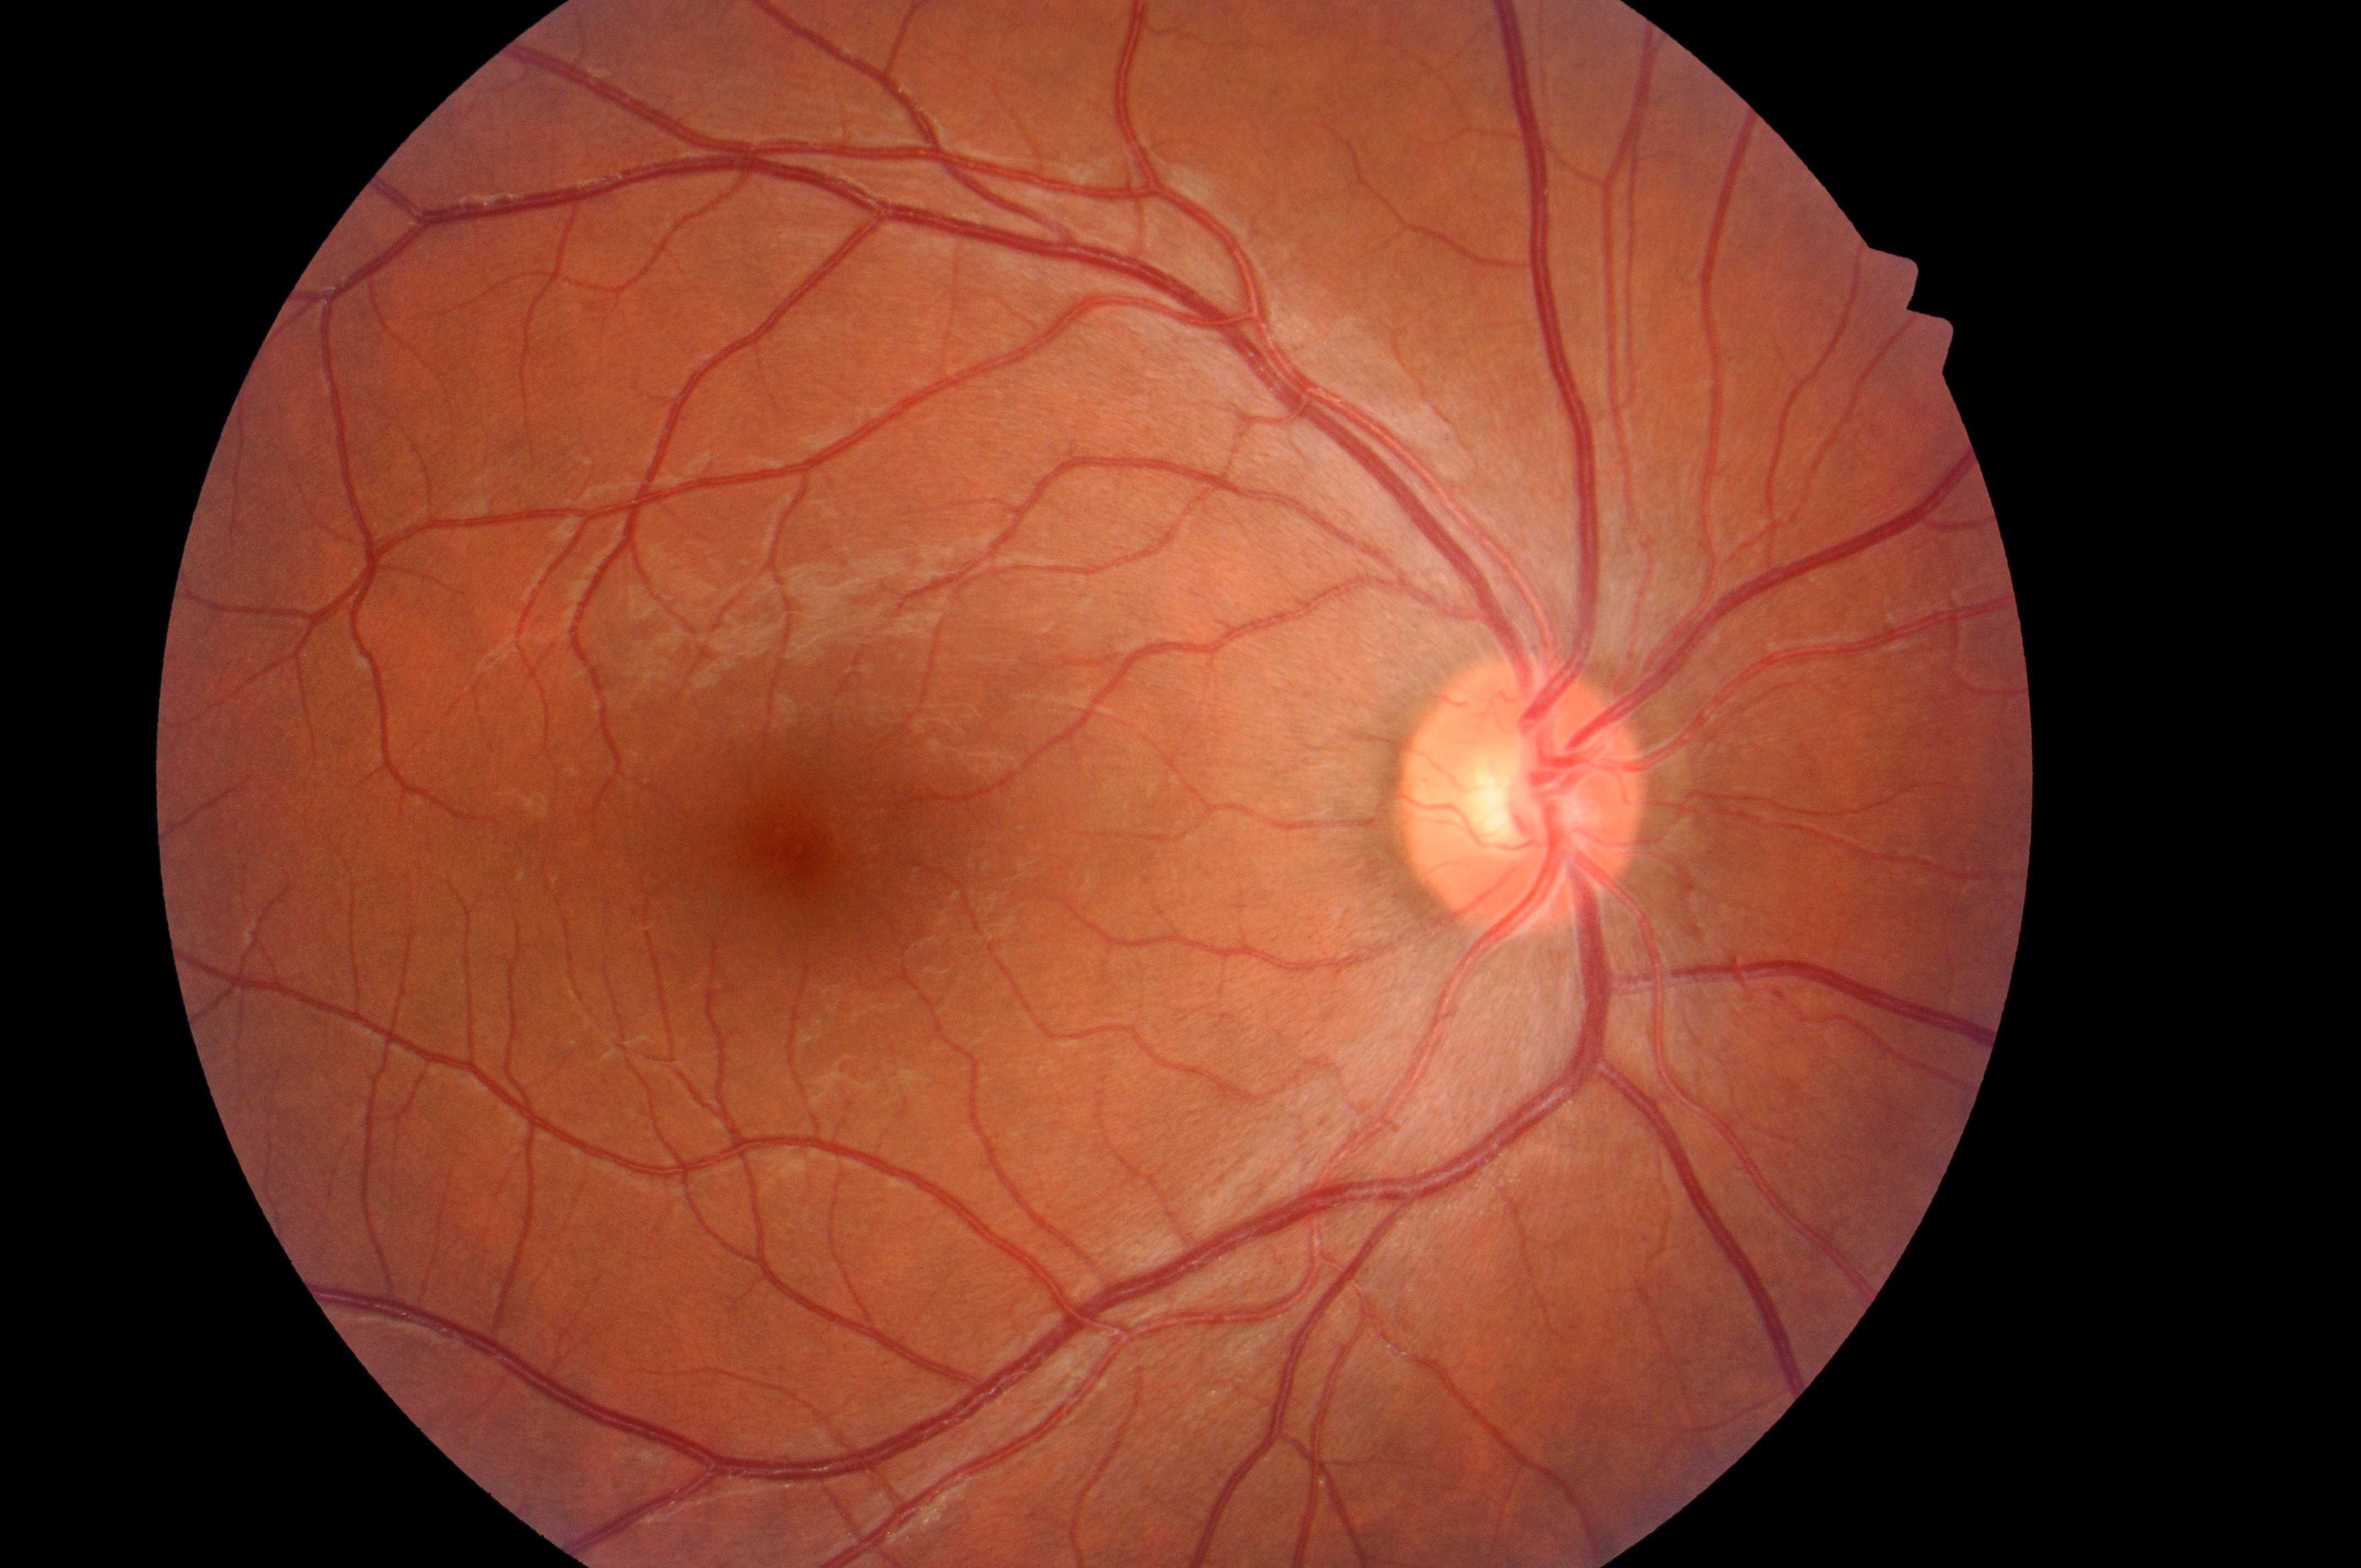 This is the oculus dexter. DR stage is 0/4. Optic disc: (1516, 806). Macular center: (802, 851). No diabetic retinopathy; no macular edema risk. DME risk: grade 0.